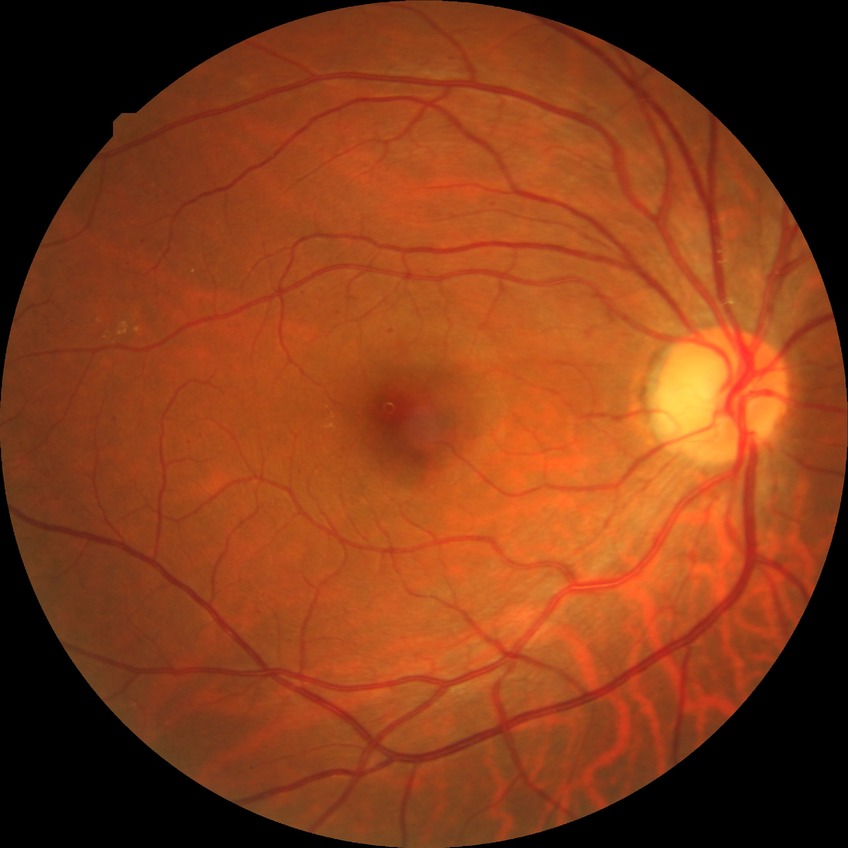
diabetic retinopathy (DR)@simple diabetic retinopathy (SDR).